RetCam wide-field infant fundus image. Acquired on the Clarity RetCam 3:
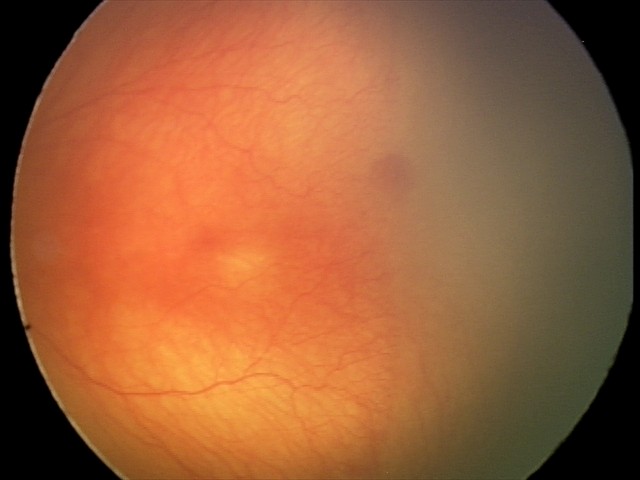 Plus disease = present
finding = aggressive retinopathy of prematurity — rapidly progressive severe ROP with prominent plus disease, often without classic stage progression